2212x1659 — 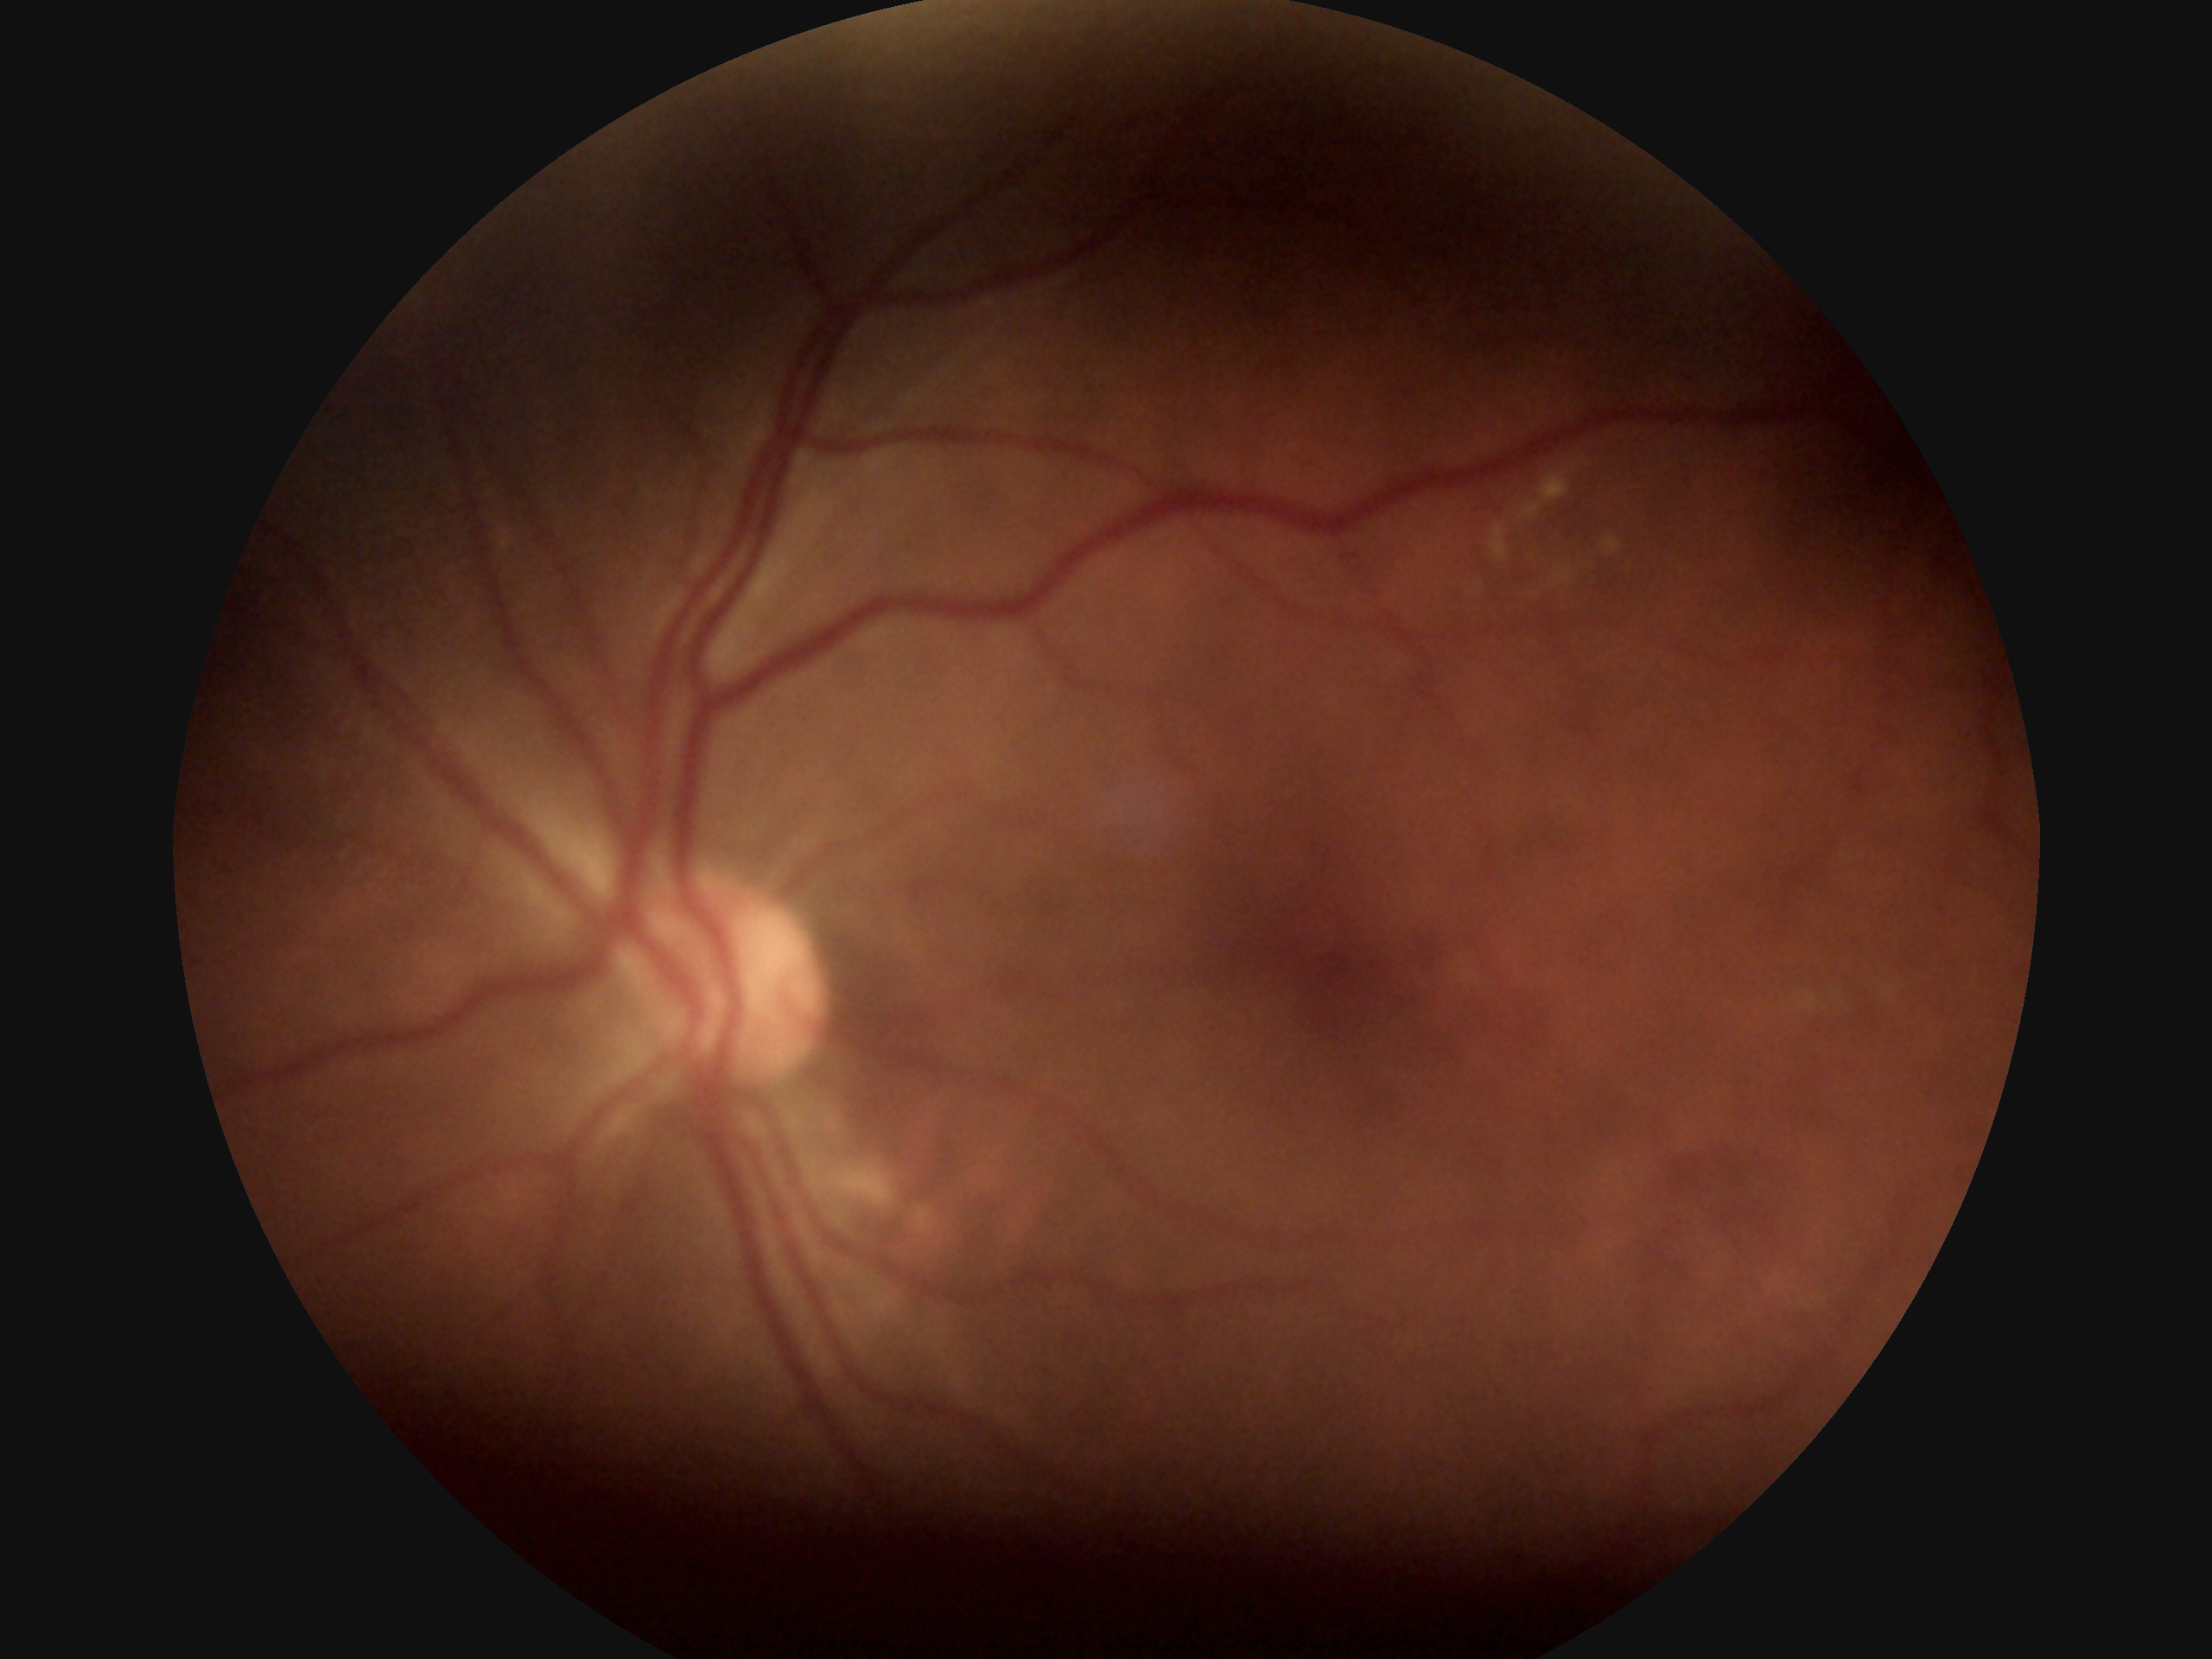

DR severity: moderate NPDR (grade 2) — more than just microaneurysms but less than severe NPDR.